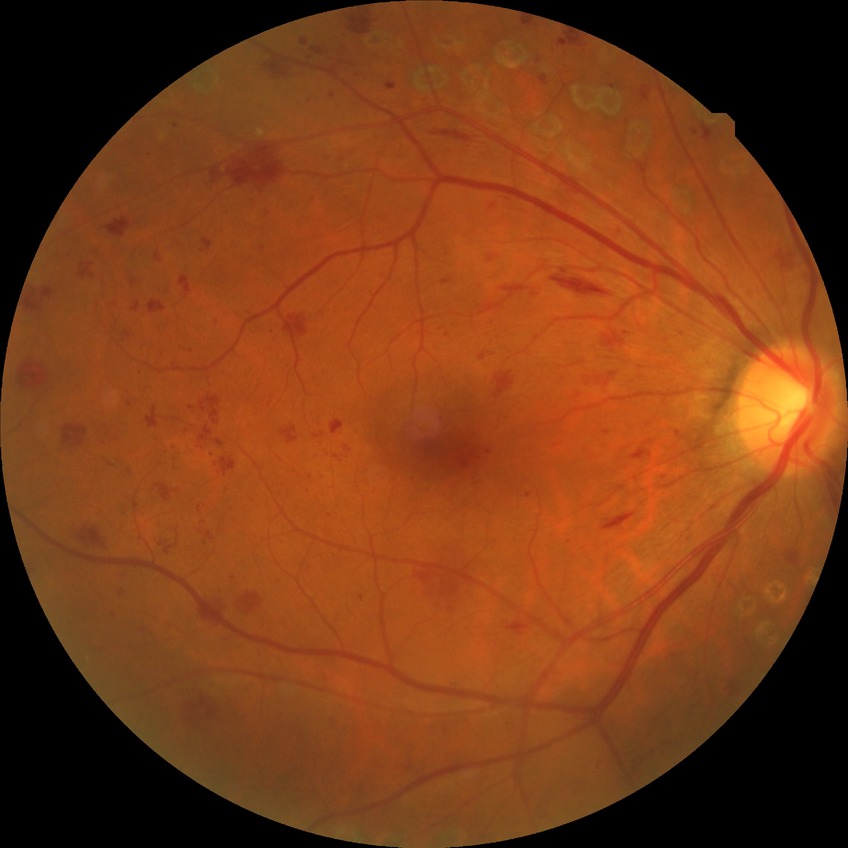
retinopathy grade = proliferative diabetic retinopathy.